Camera: NIDEK AFC-230 · without pupil dilation:
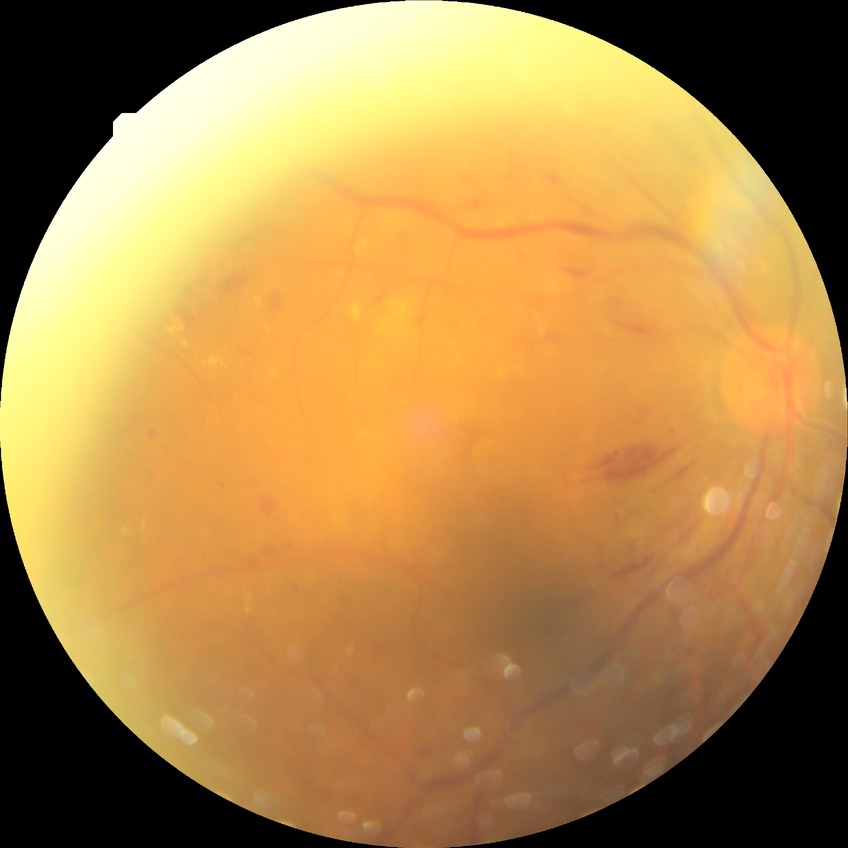
proliferative_class: non-proliferative diabetic retinopathy
davis_grade: pre-proliferative diabetic retinopathy (PPDR)